Axial length 24.31 mm; color fundus image; 61 years old; 30° field of view; IOP 14 mmHg
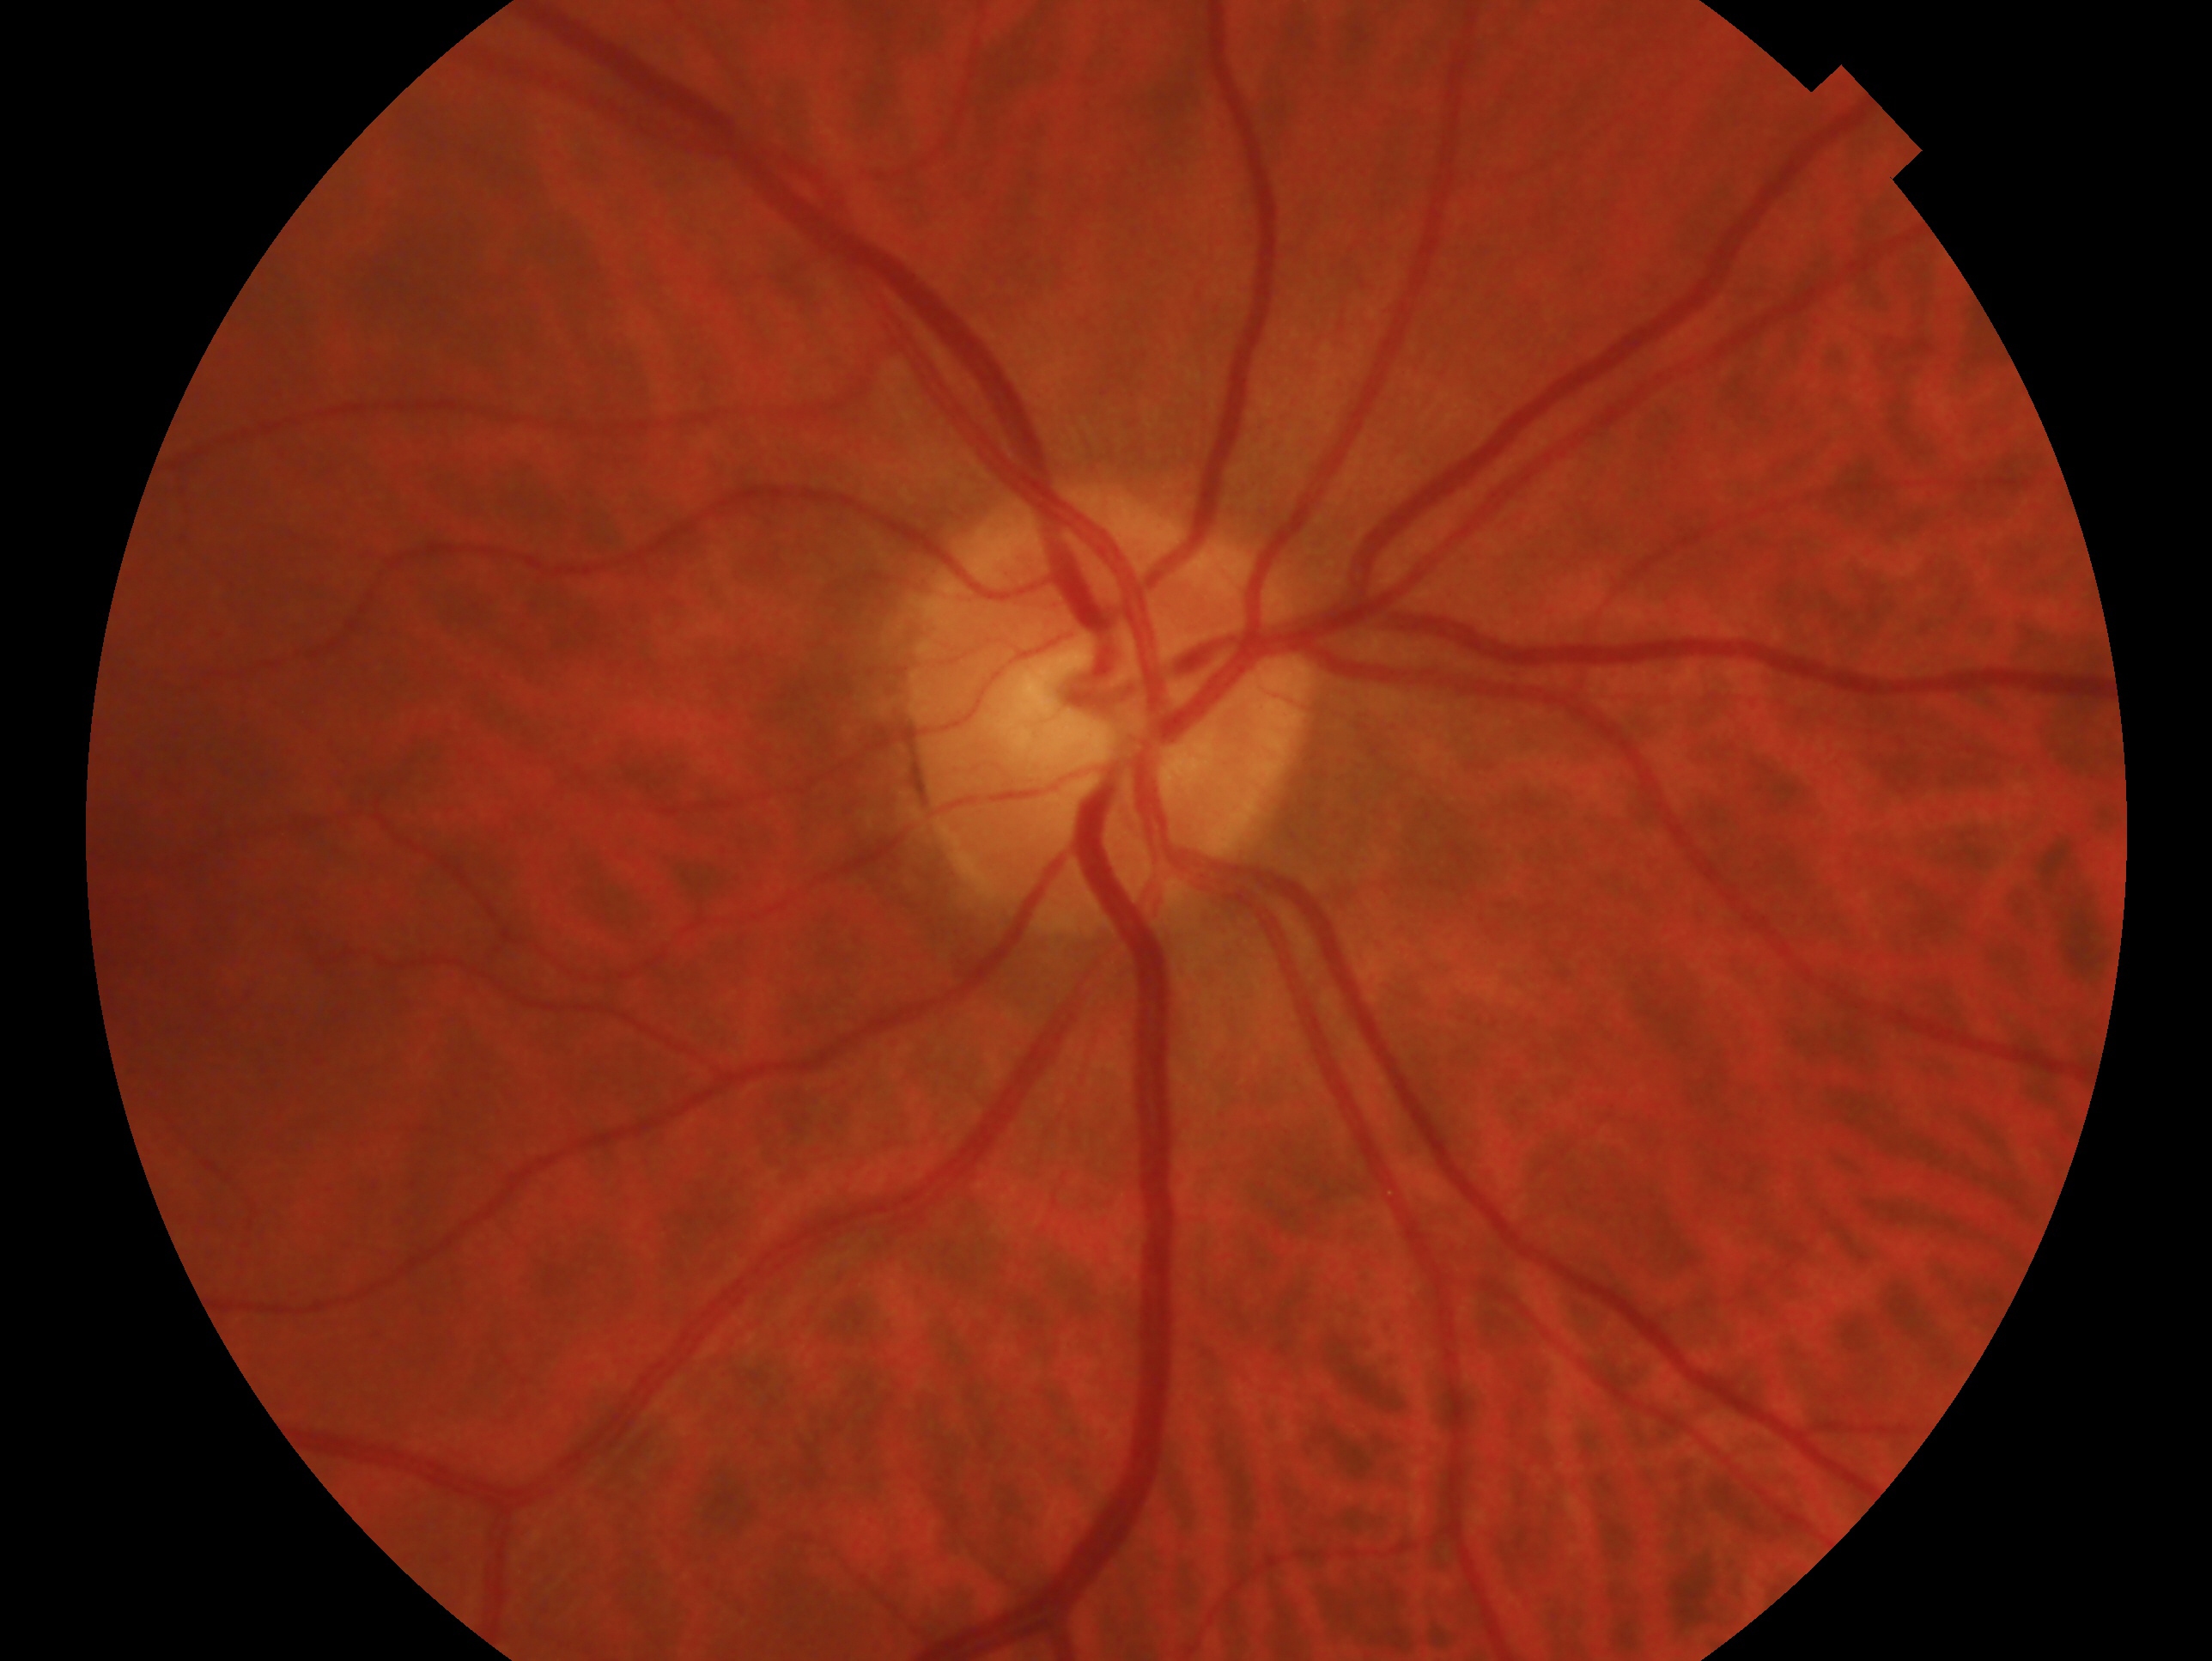
This is the right eye. Clinical classification: glaucoma cannot be excluded — risk factors or equivocal findings for glaucoma without a confirmed diagnosis.